2352x1568px. FOV: 45 degrees. Fundus photo:
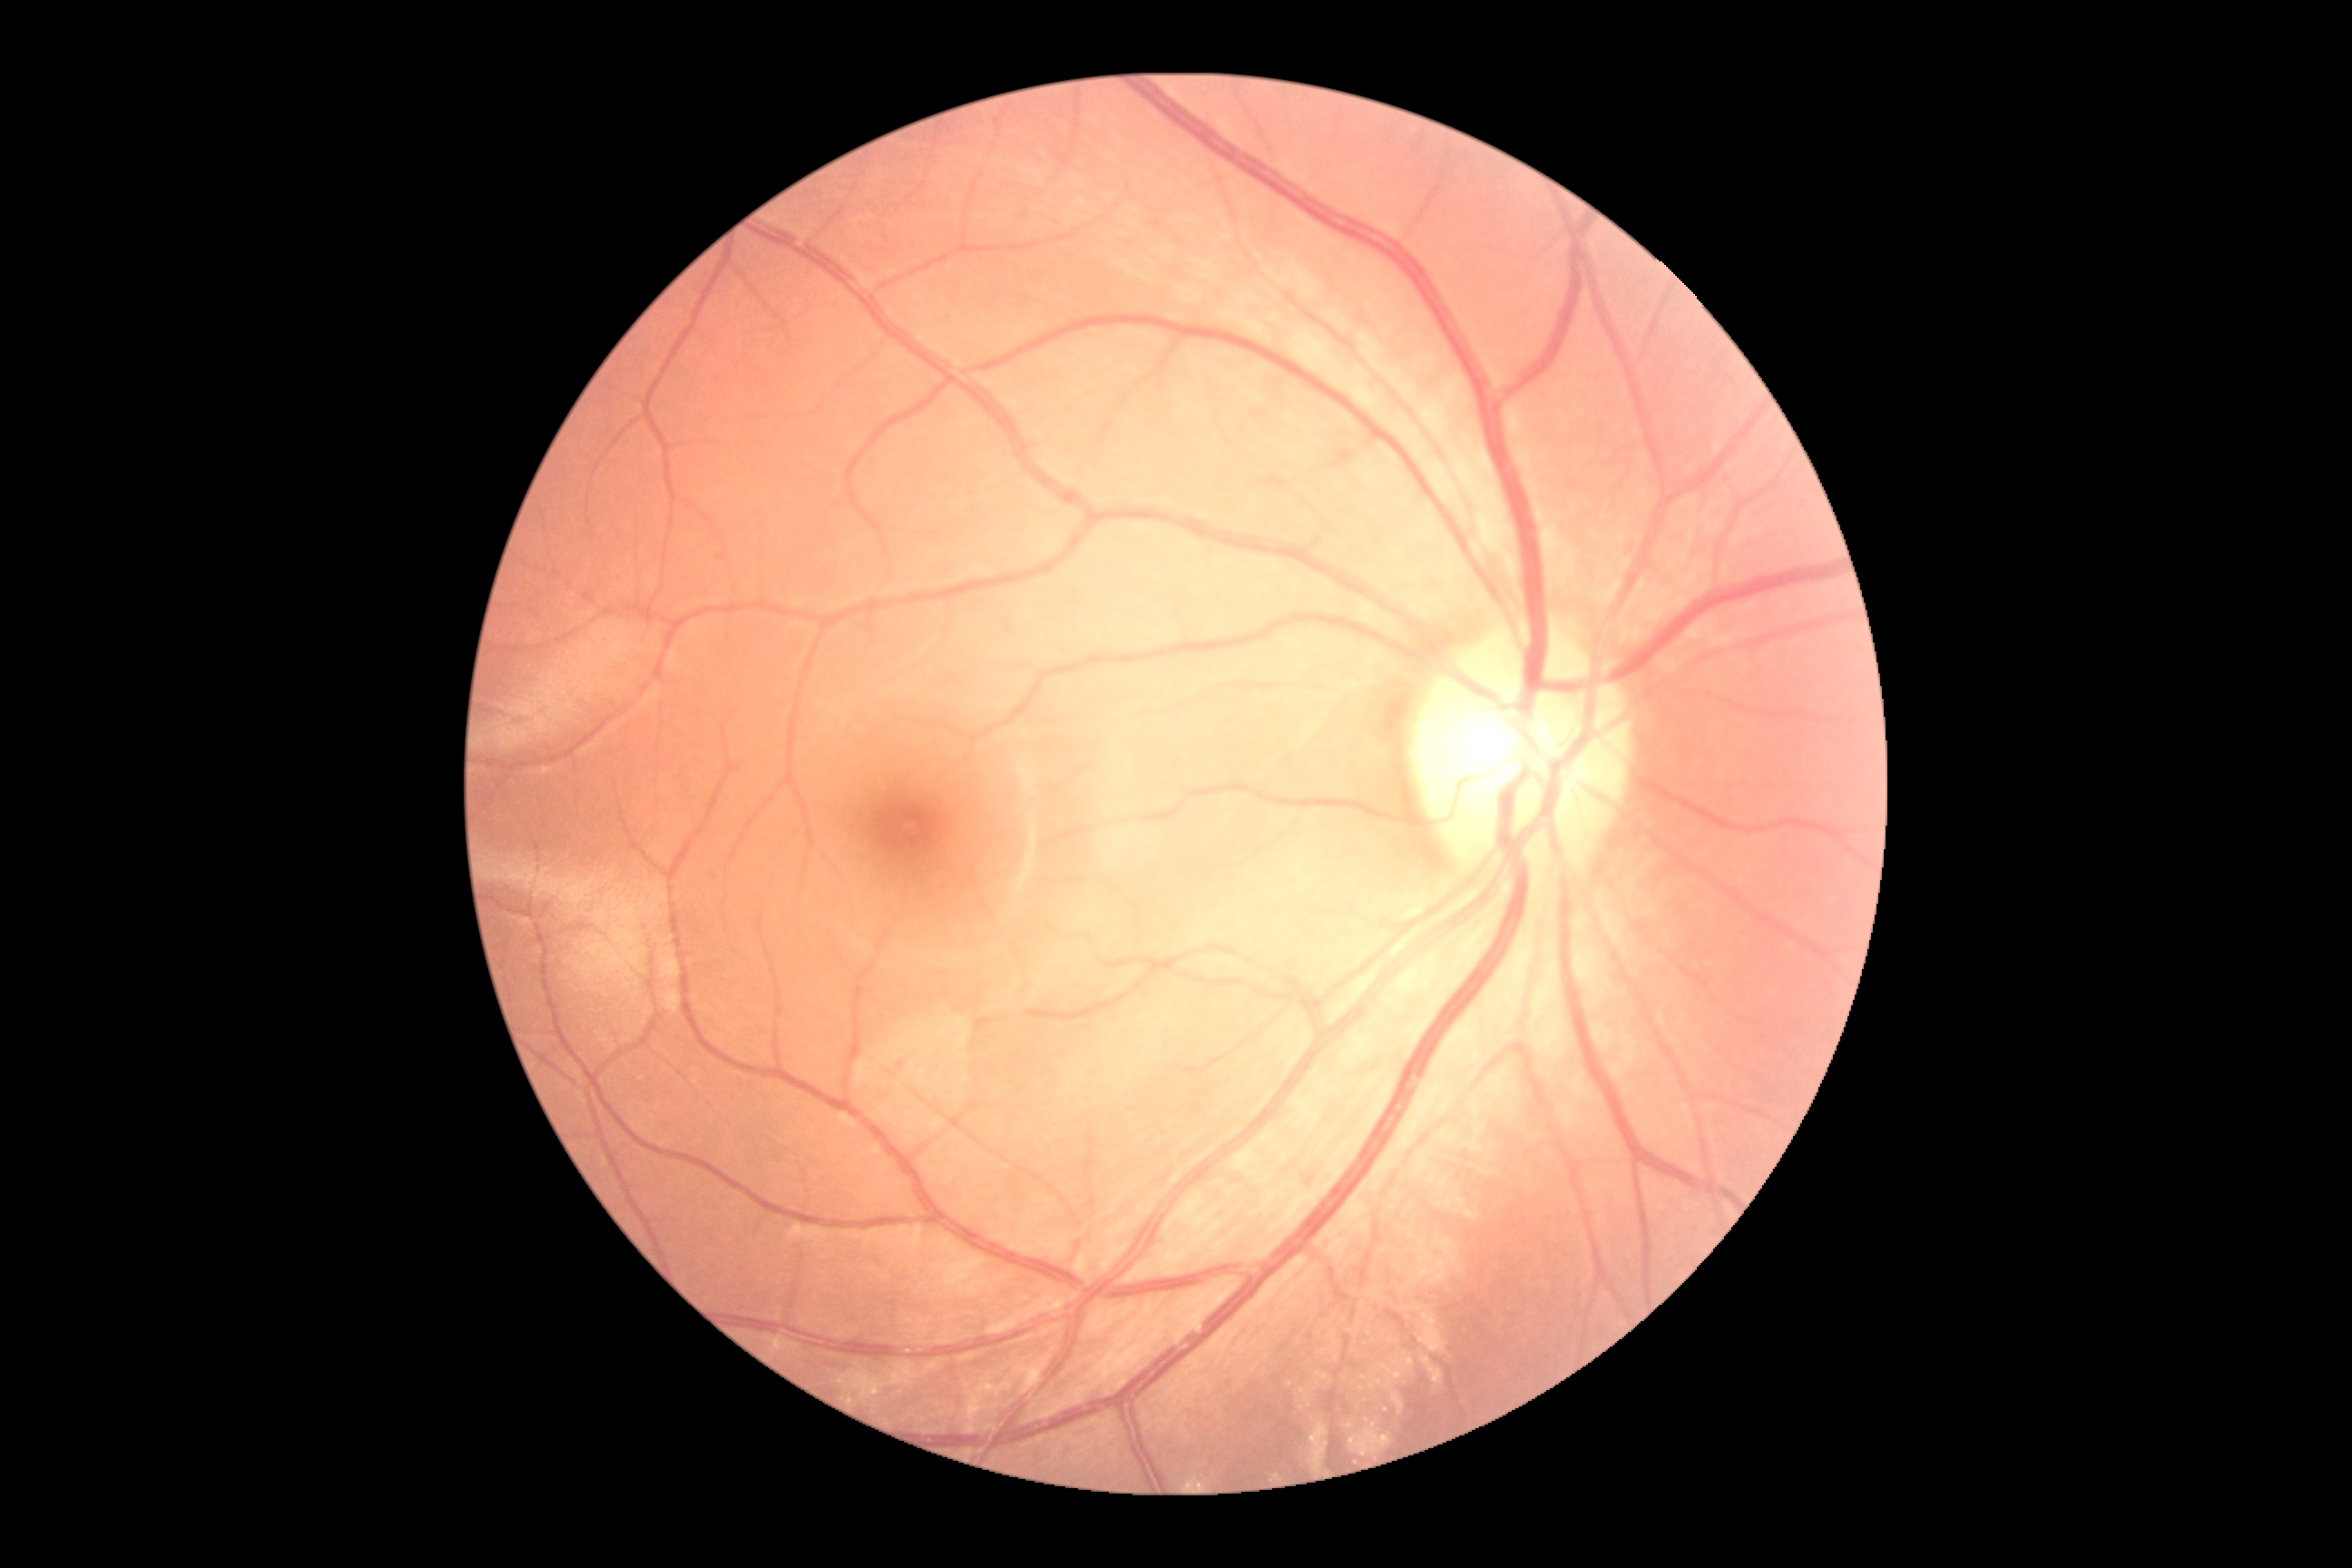

{
  "dr_grade": "0/4",
  "dr_impression": "no apparent DR"
}